FOV: 45 degrees.
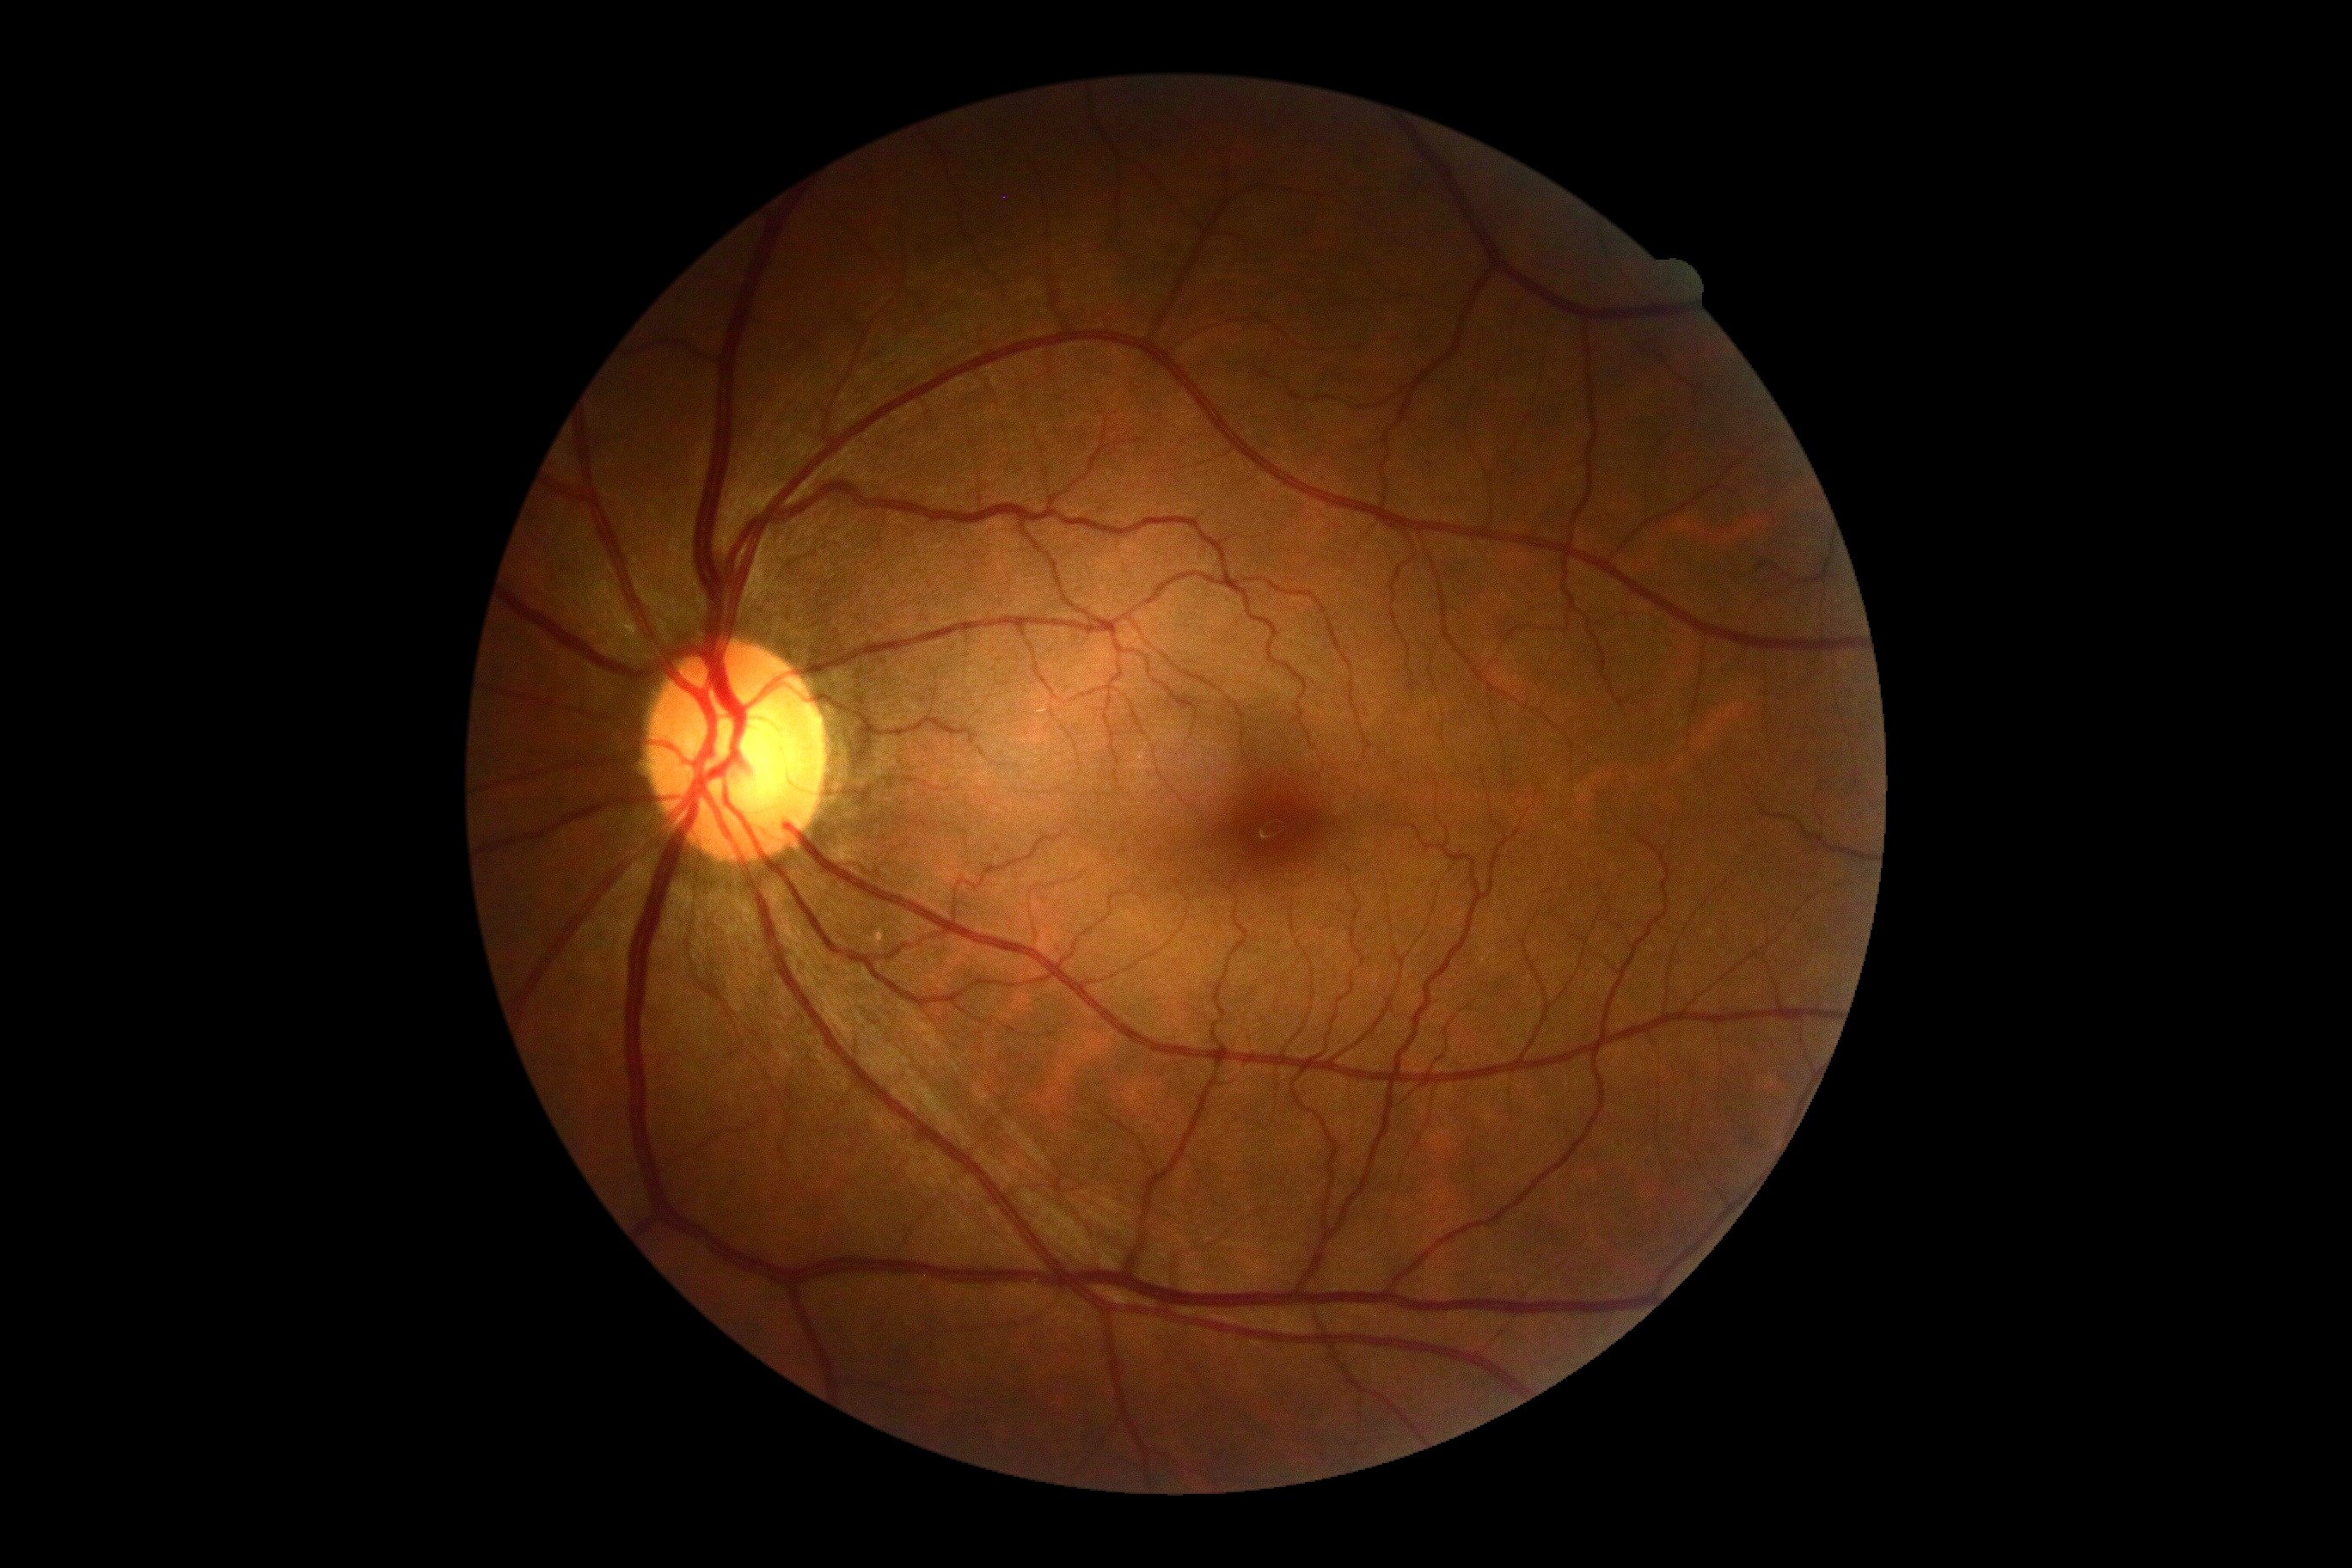

Findings:
* DR impression — no DR findings
* diabetic retinopathy (DR) — grade 0 (no apparent retinopathy)